Pediatric retinal photograph (wide-field); 1440x1080: 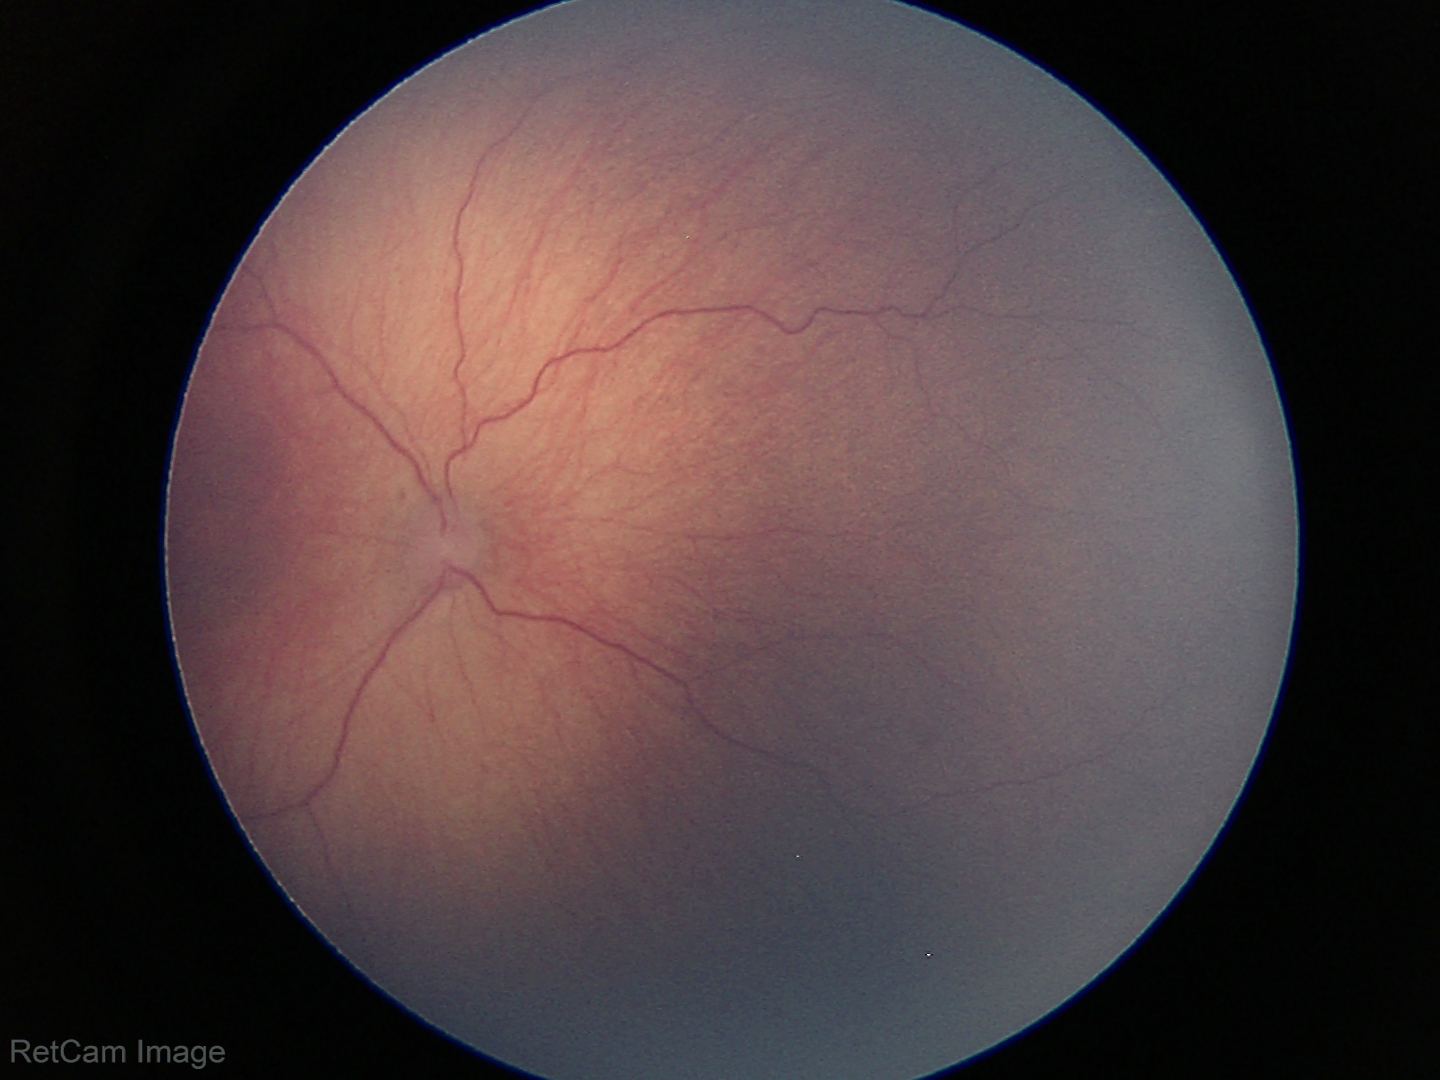 No plus disease.
Series diagnosed as ROP stage 1.